848 x 848 pixels. Davis DR grading
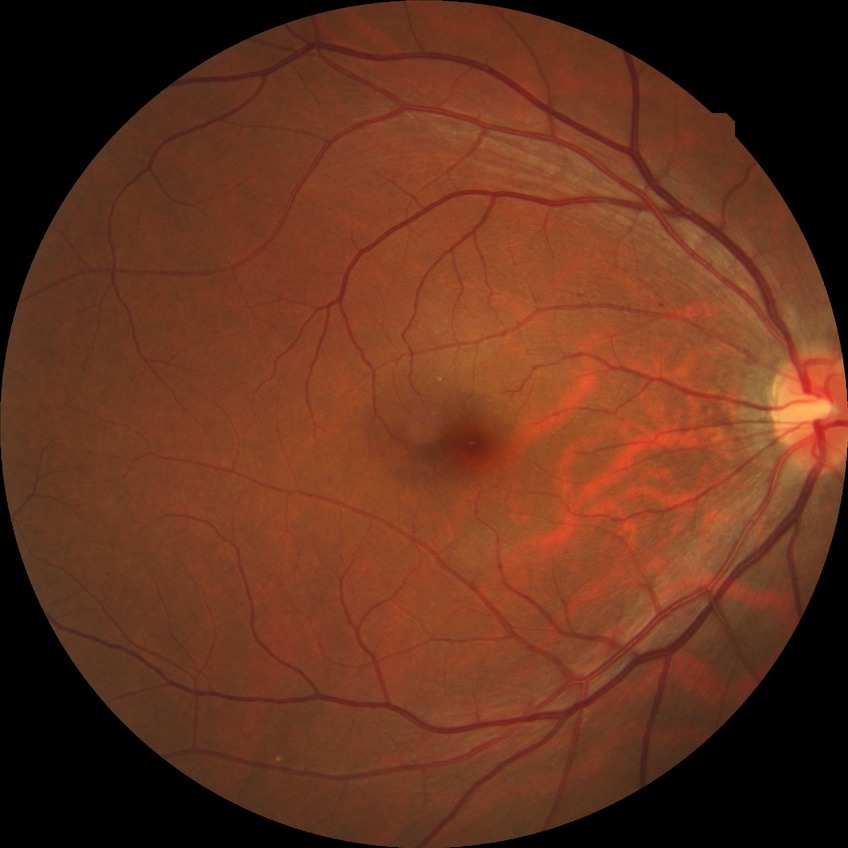 The retinopathy is classified as non-proliferative diabetic retinopathy. Diabetic retinopathy (DR) is simple diabetic retinopathy (SDR).